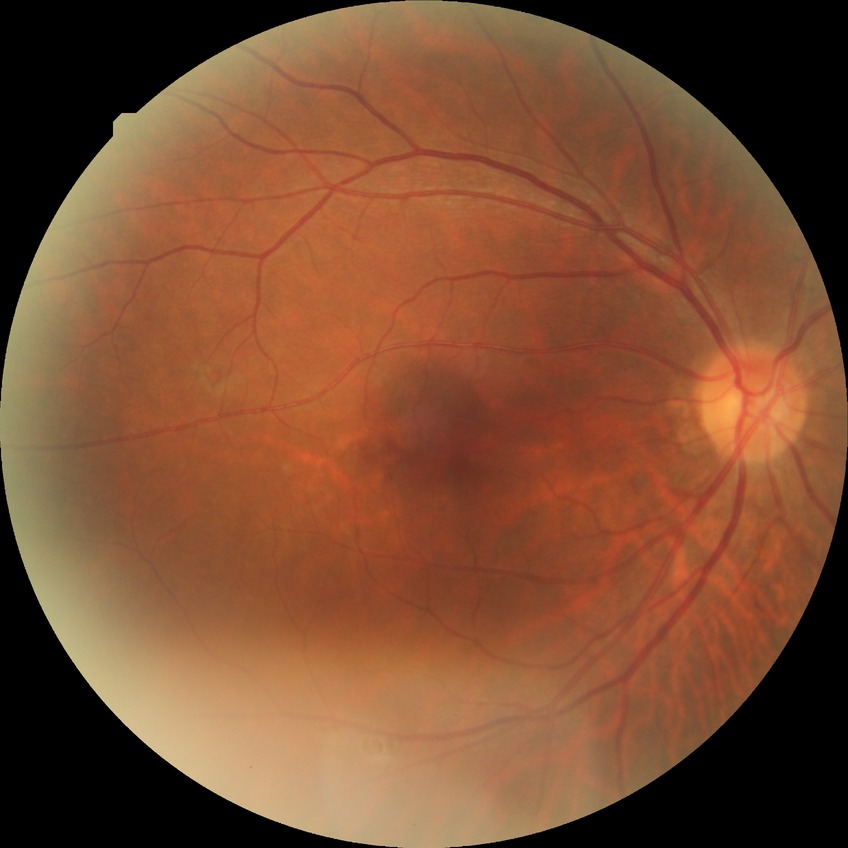
diabetic retinopathy (DR)@no diabetic retinopathy (NDR).